1932x1932px — 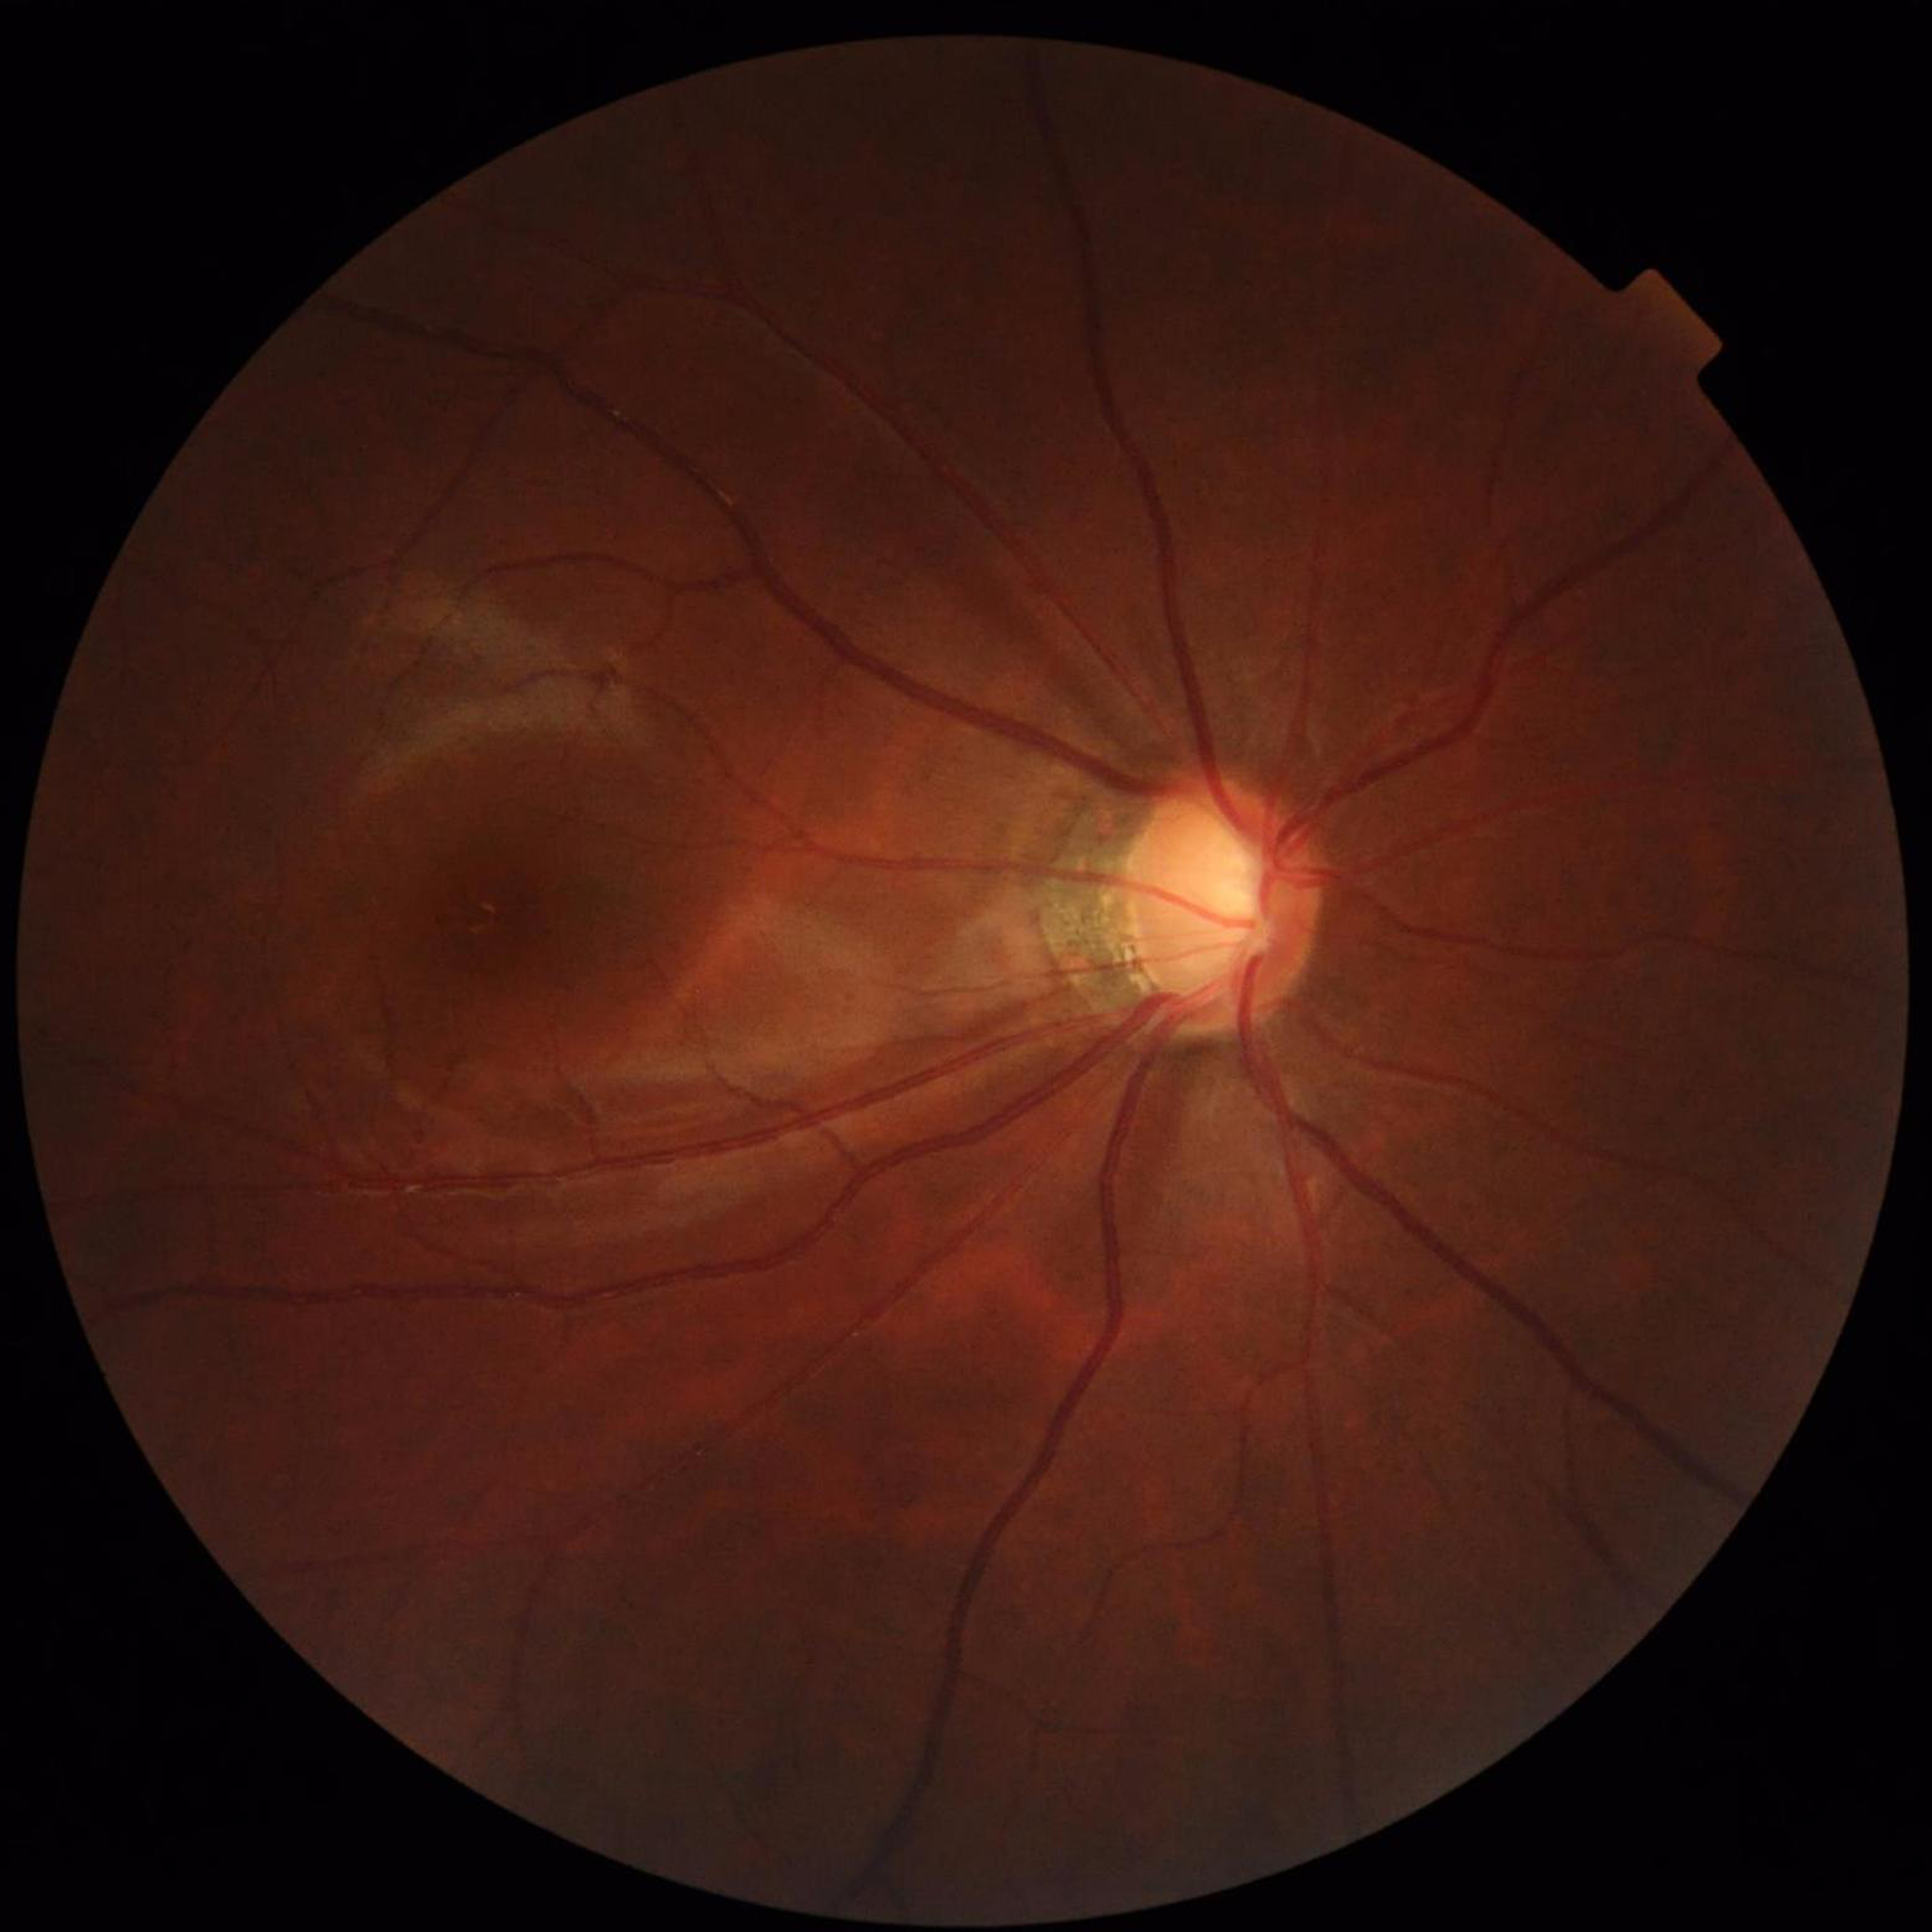

Eye affected by glaucoma.